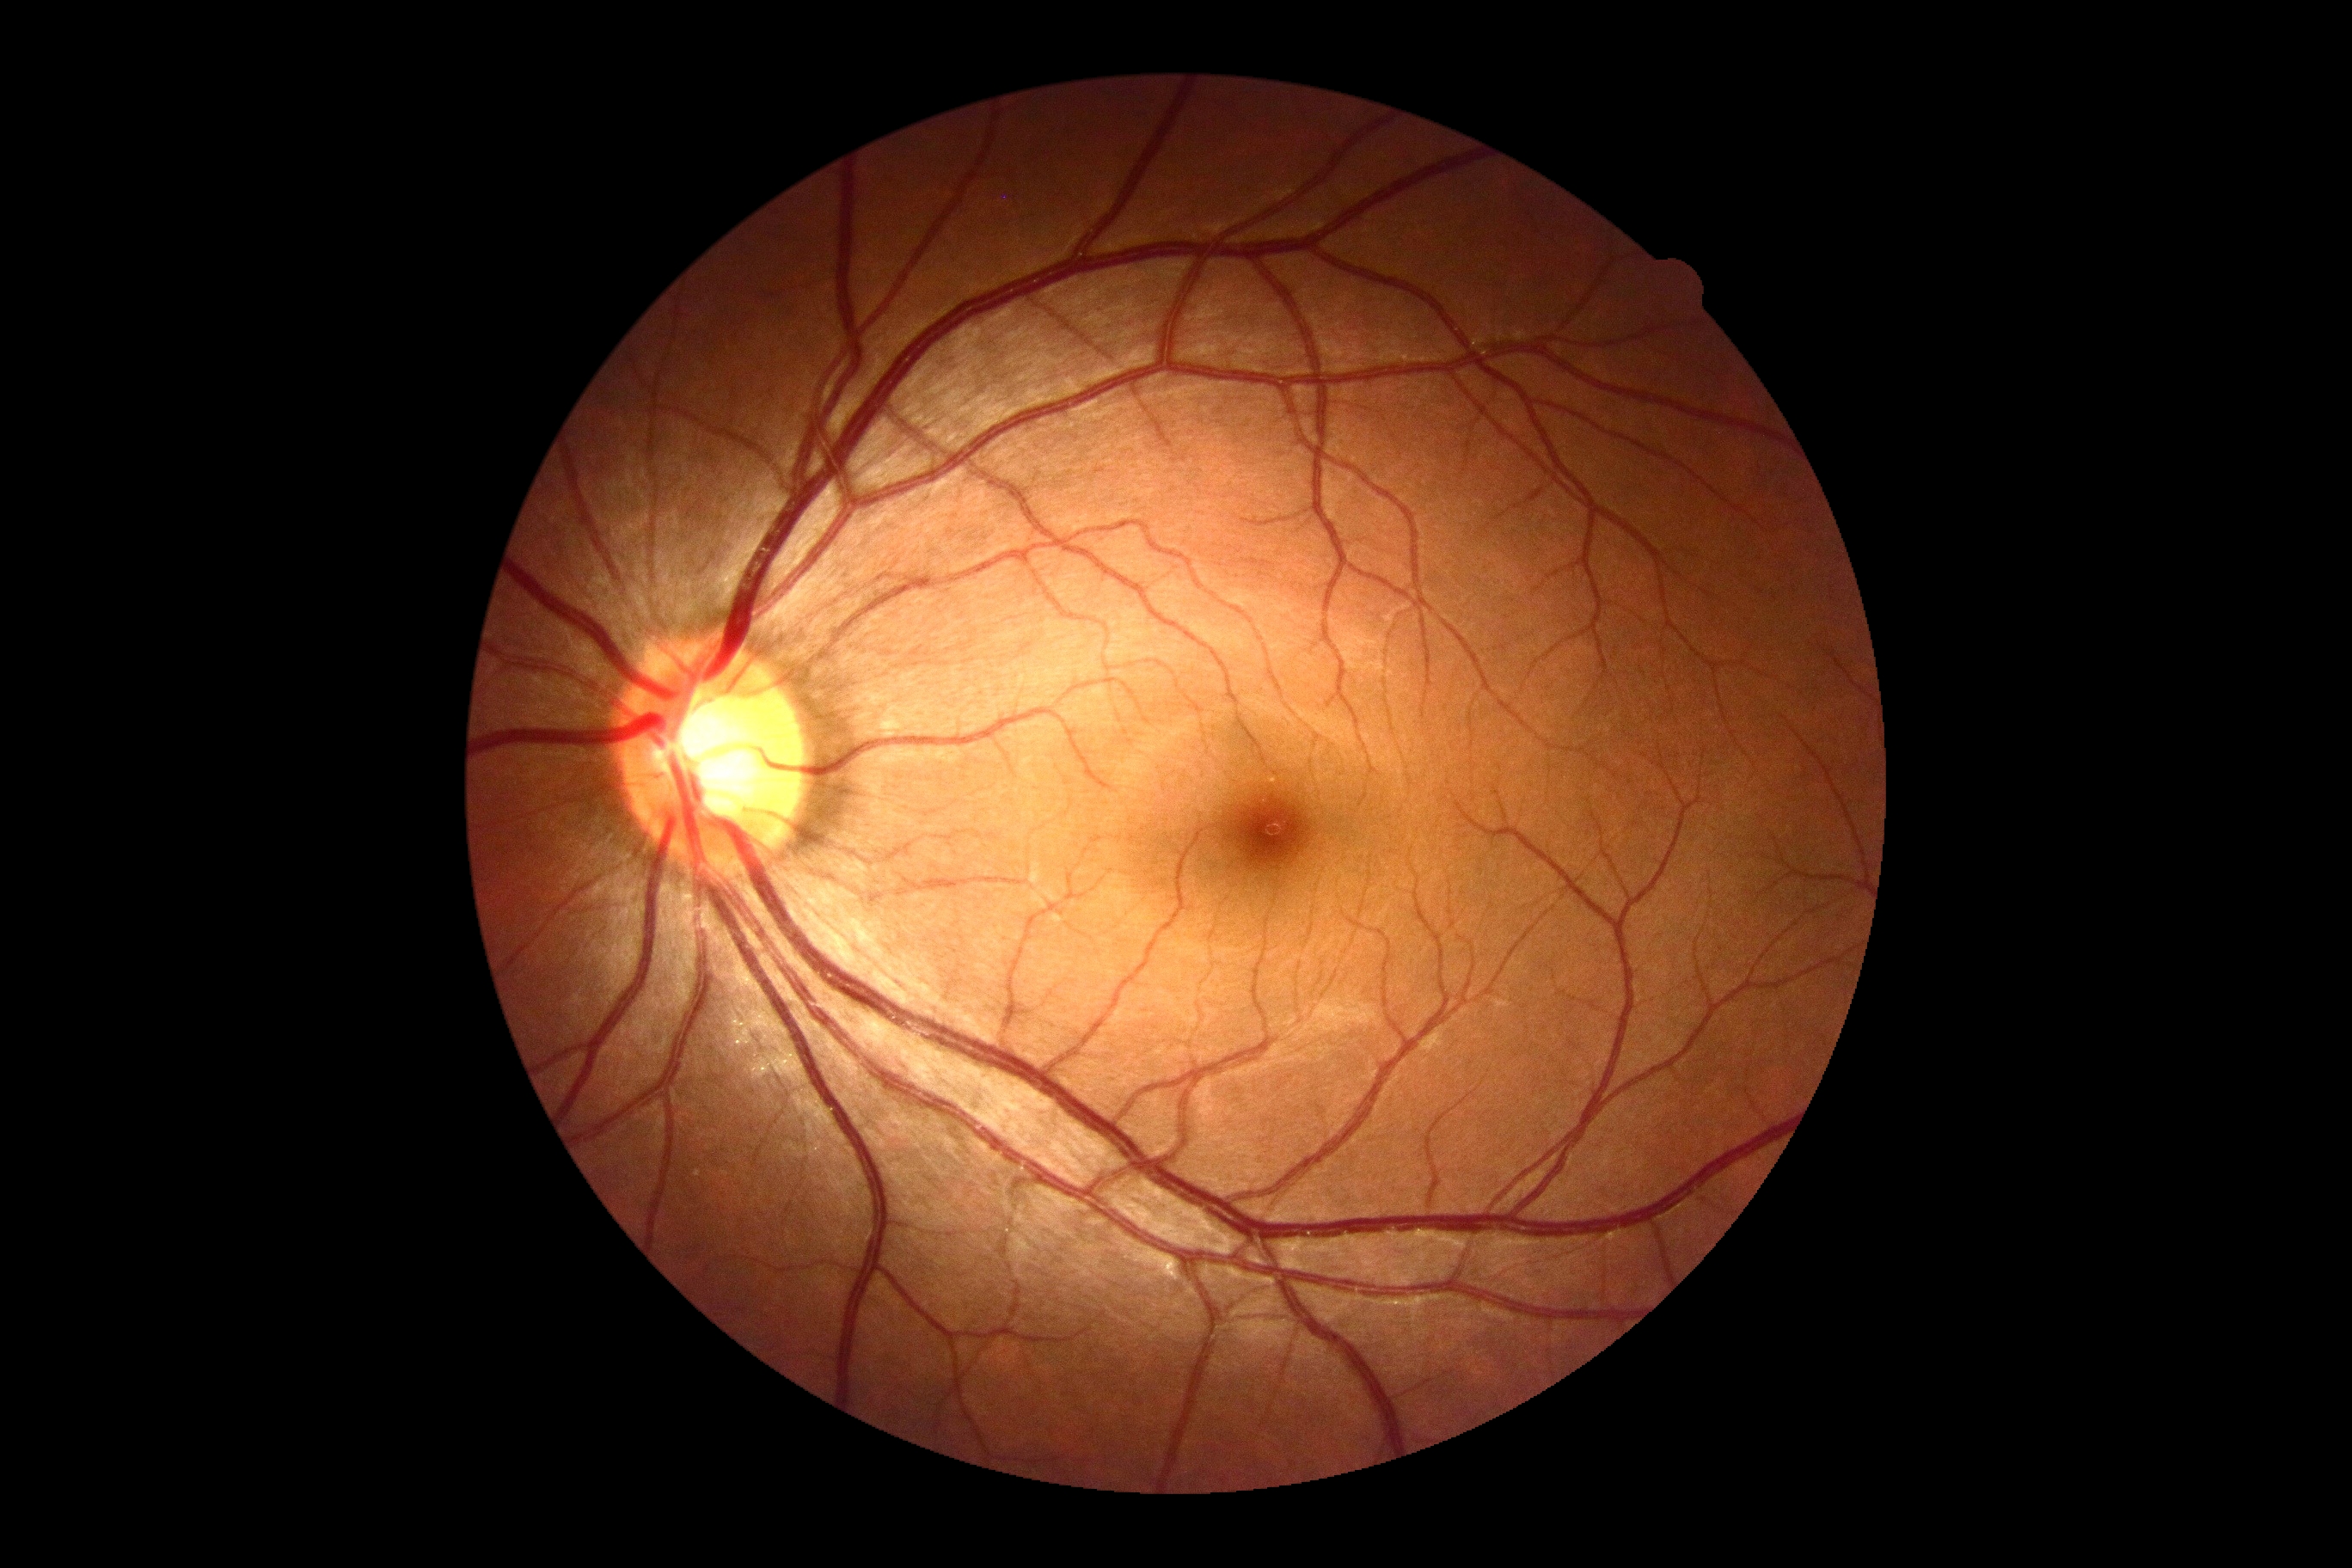

No signs of diabetic retinopathy. Diabetic retinopathy (DR) is grade 0 (no apparent retinopathy).